1240x1240; camera: Phoenix ICON (100° FOV); wide-field fundus photograph from neonatal ROP screening — 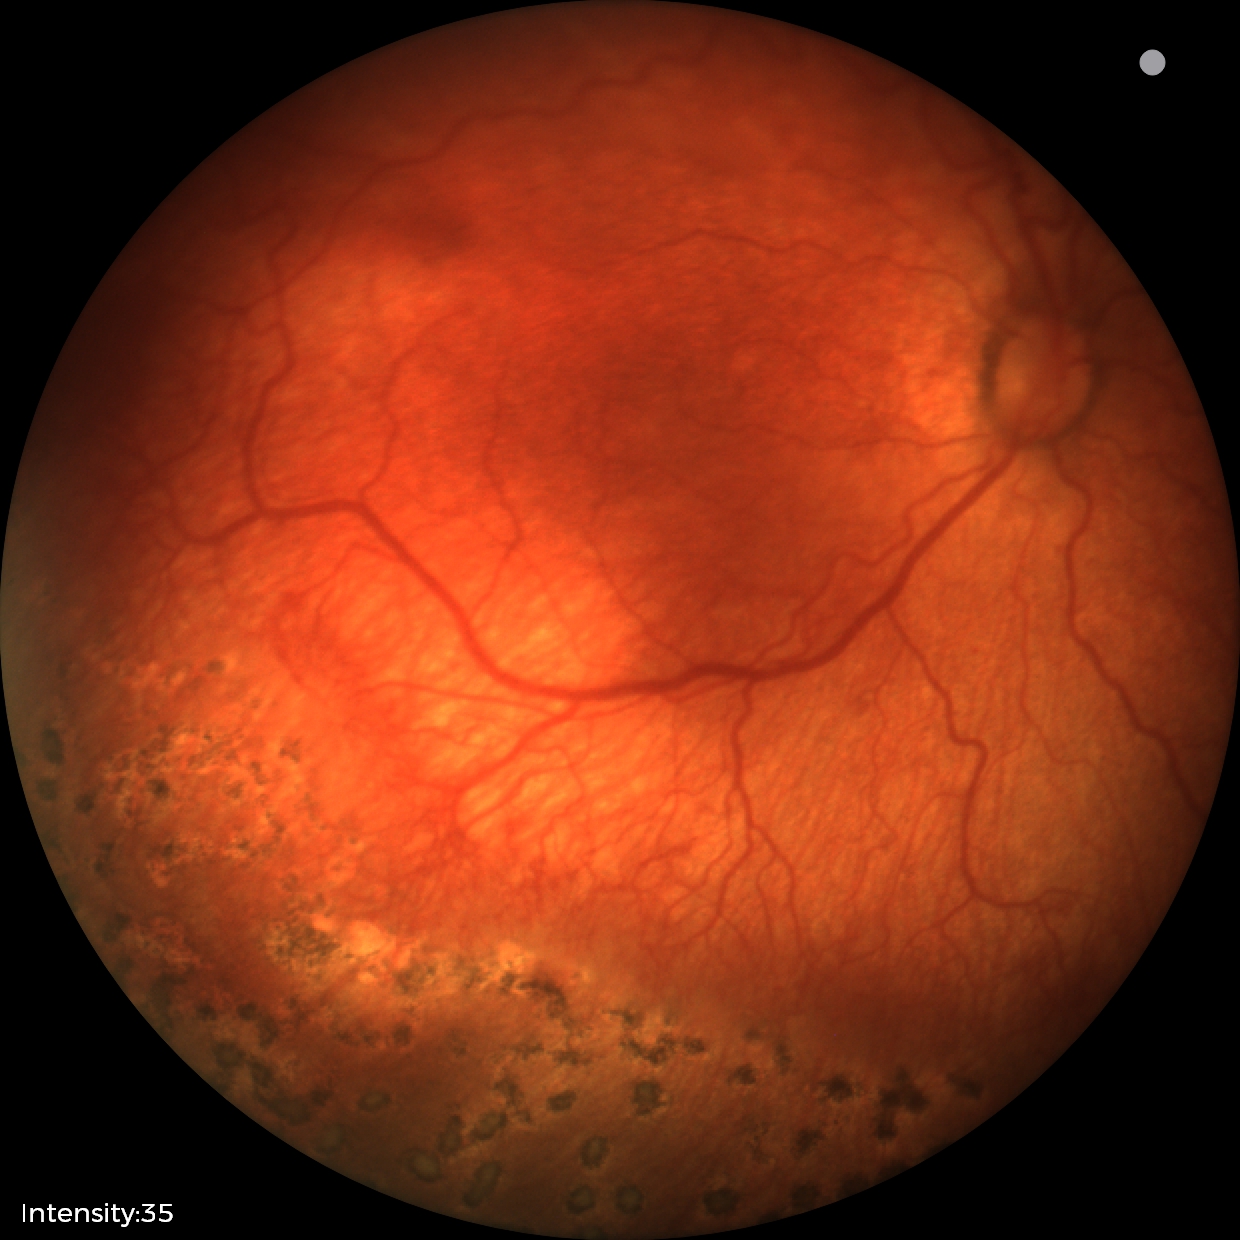 Retinopathy of prematurity stage: 1 — demarcation line between vascular and avascular retina, plus disease: present.